Image size 512x512, color fundus photograph.
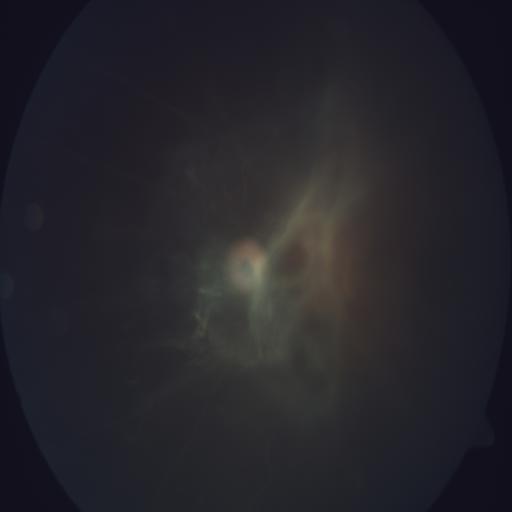

Showing retinal traction.